45-degree field of view · 1932 by 1932 pixels · retinal fundus photograph
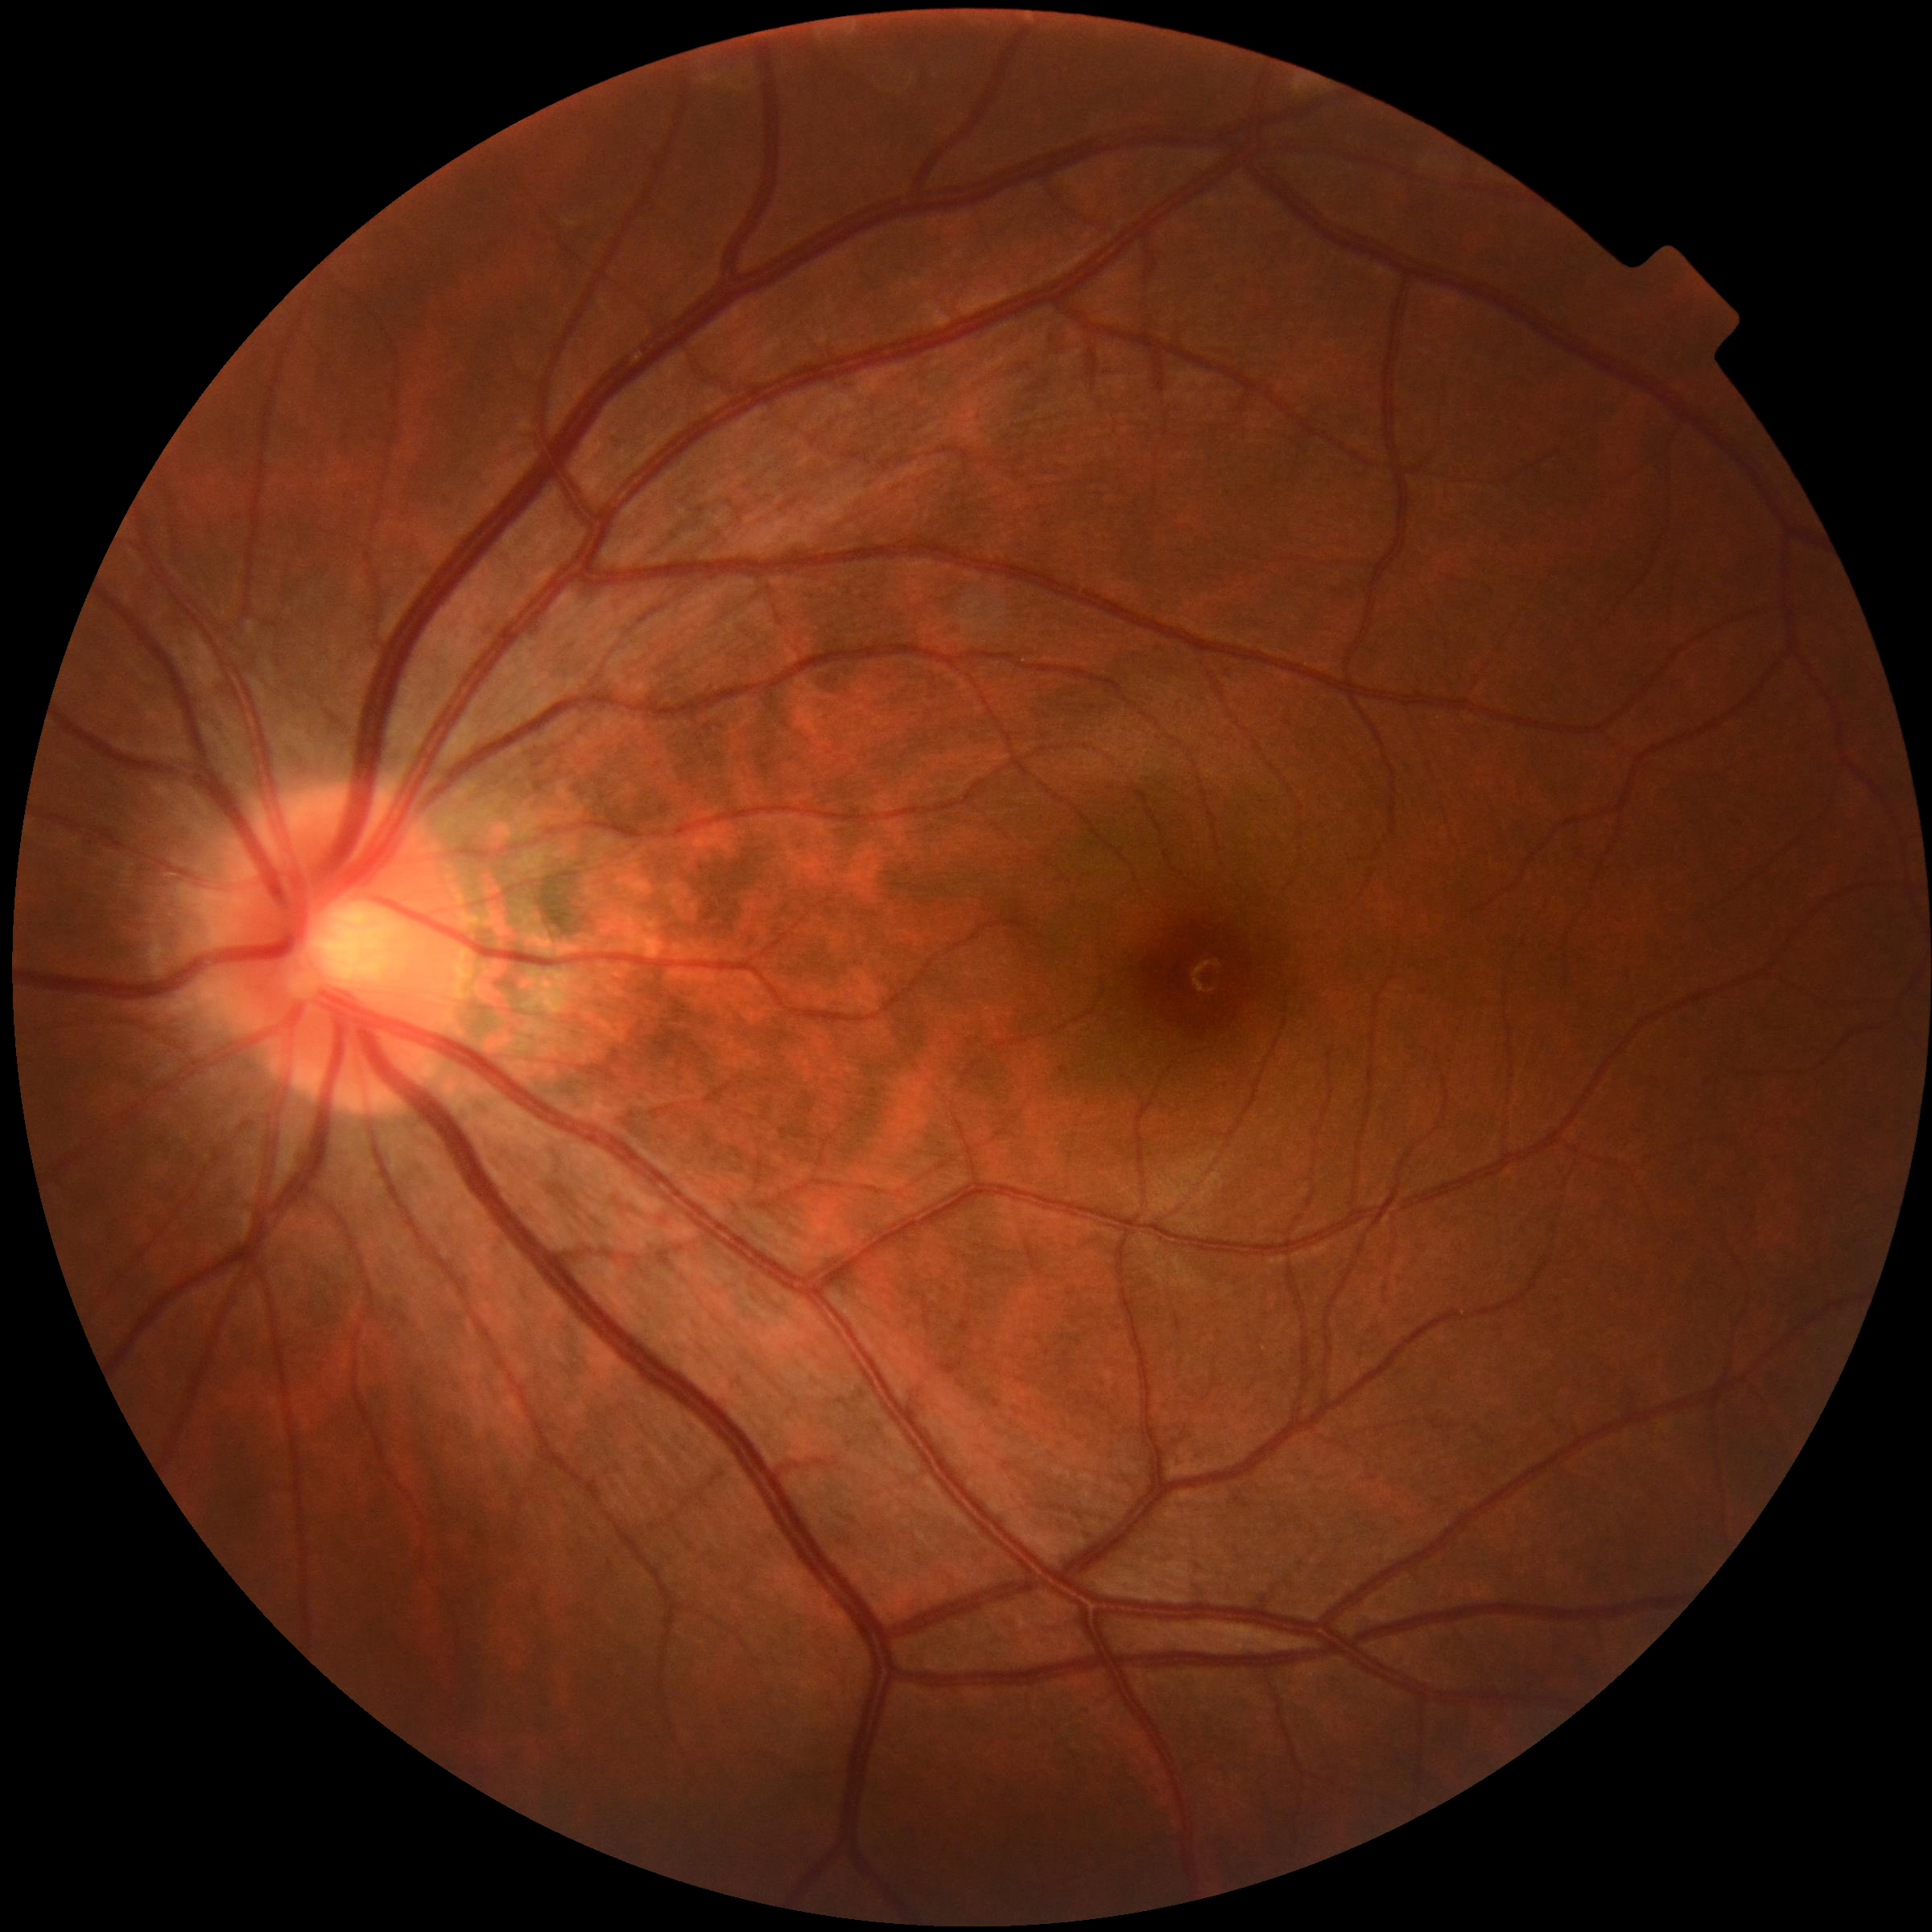

retinopathy: grade 0 (no apparent retinopathy) — no visible signs of diabetic retinopathy.